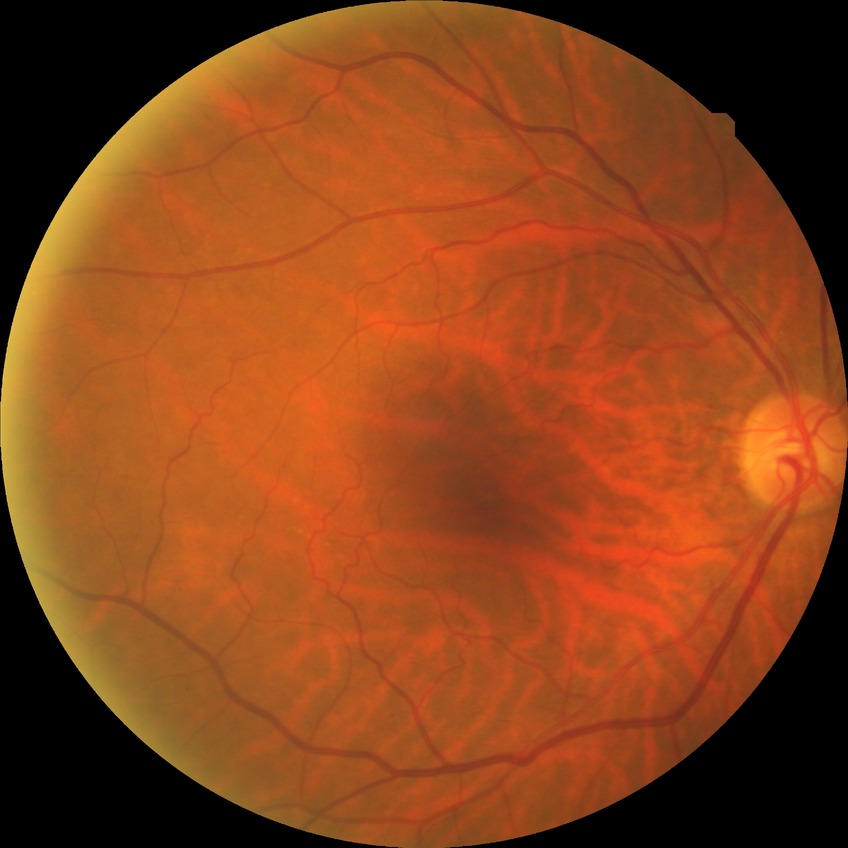
diabetic retinopathy (DR): NDR (no diabetic retinopathy).